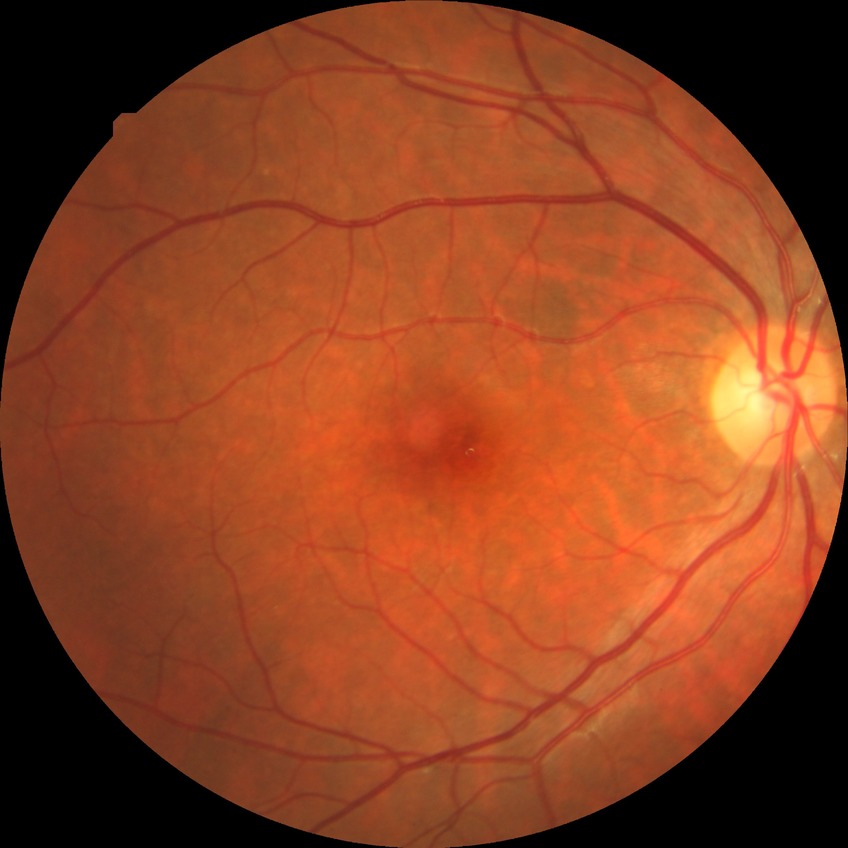

diabetic retinopathy stage: no diabetic retinopathy.